CFP:
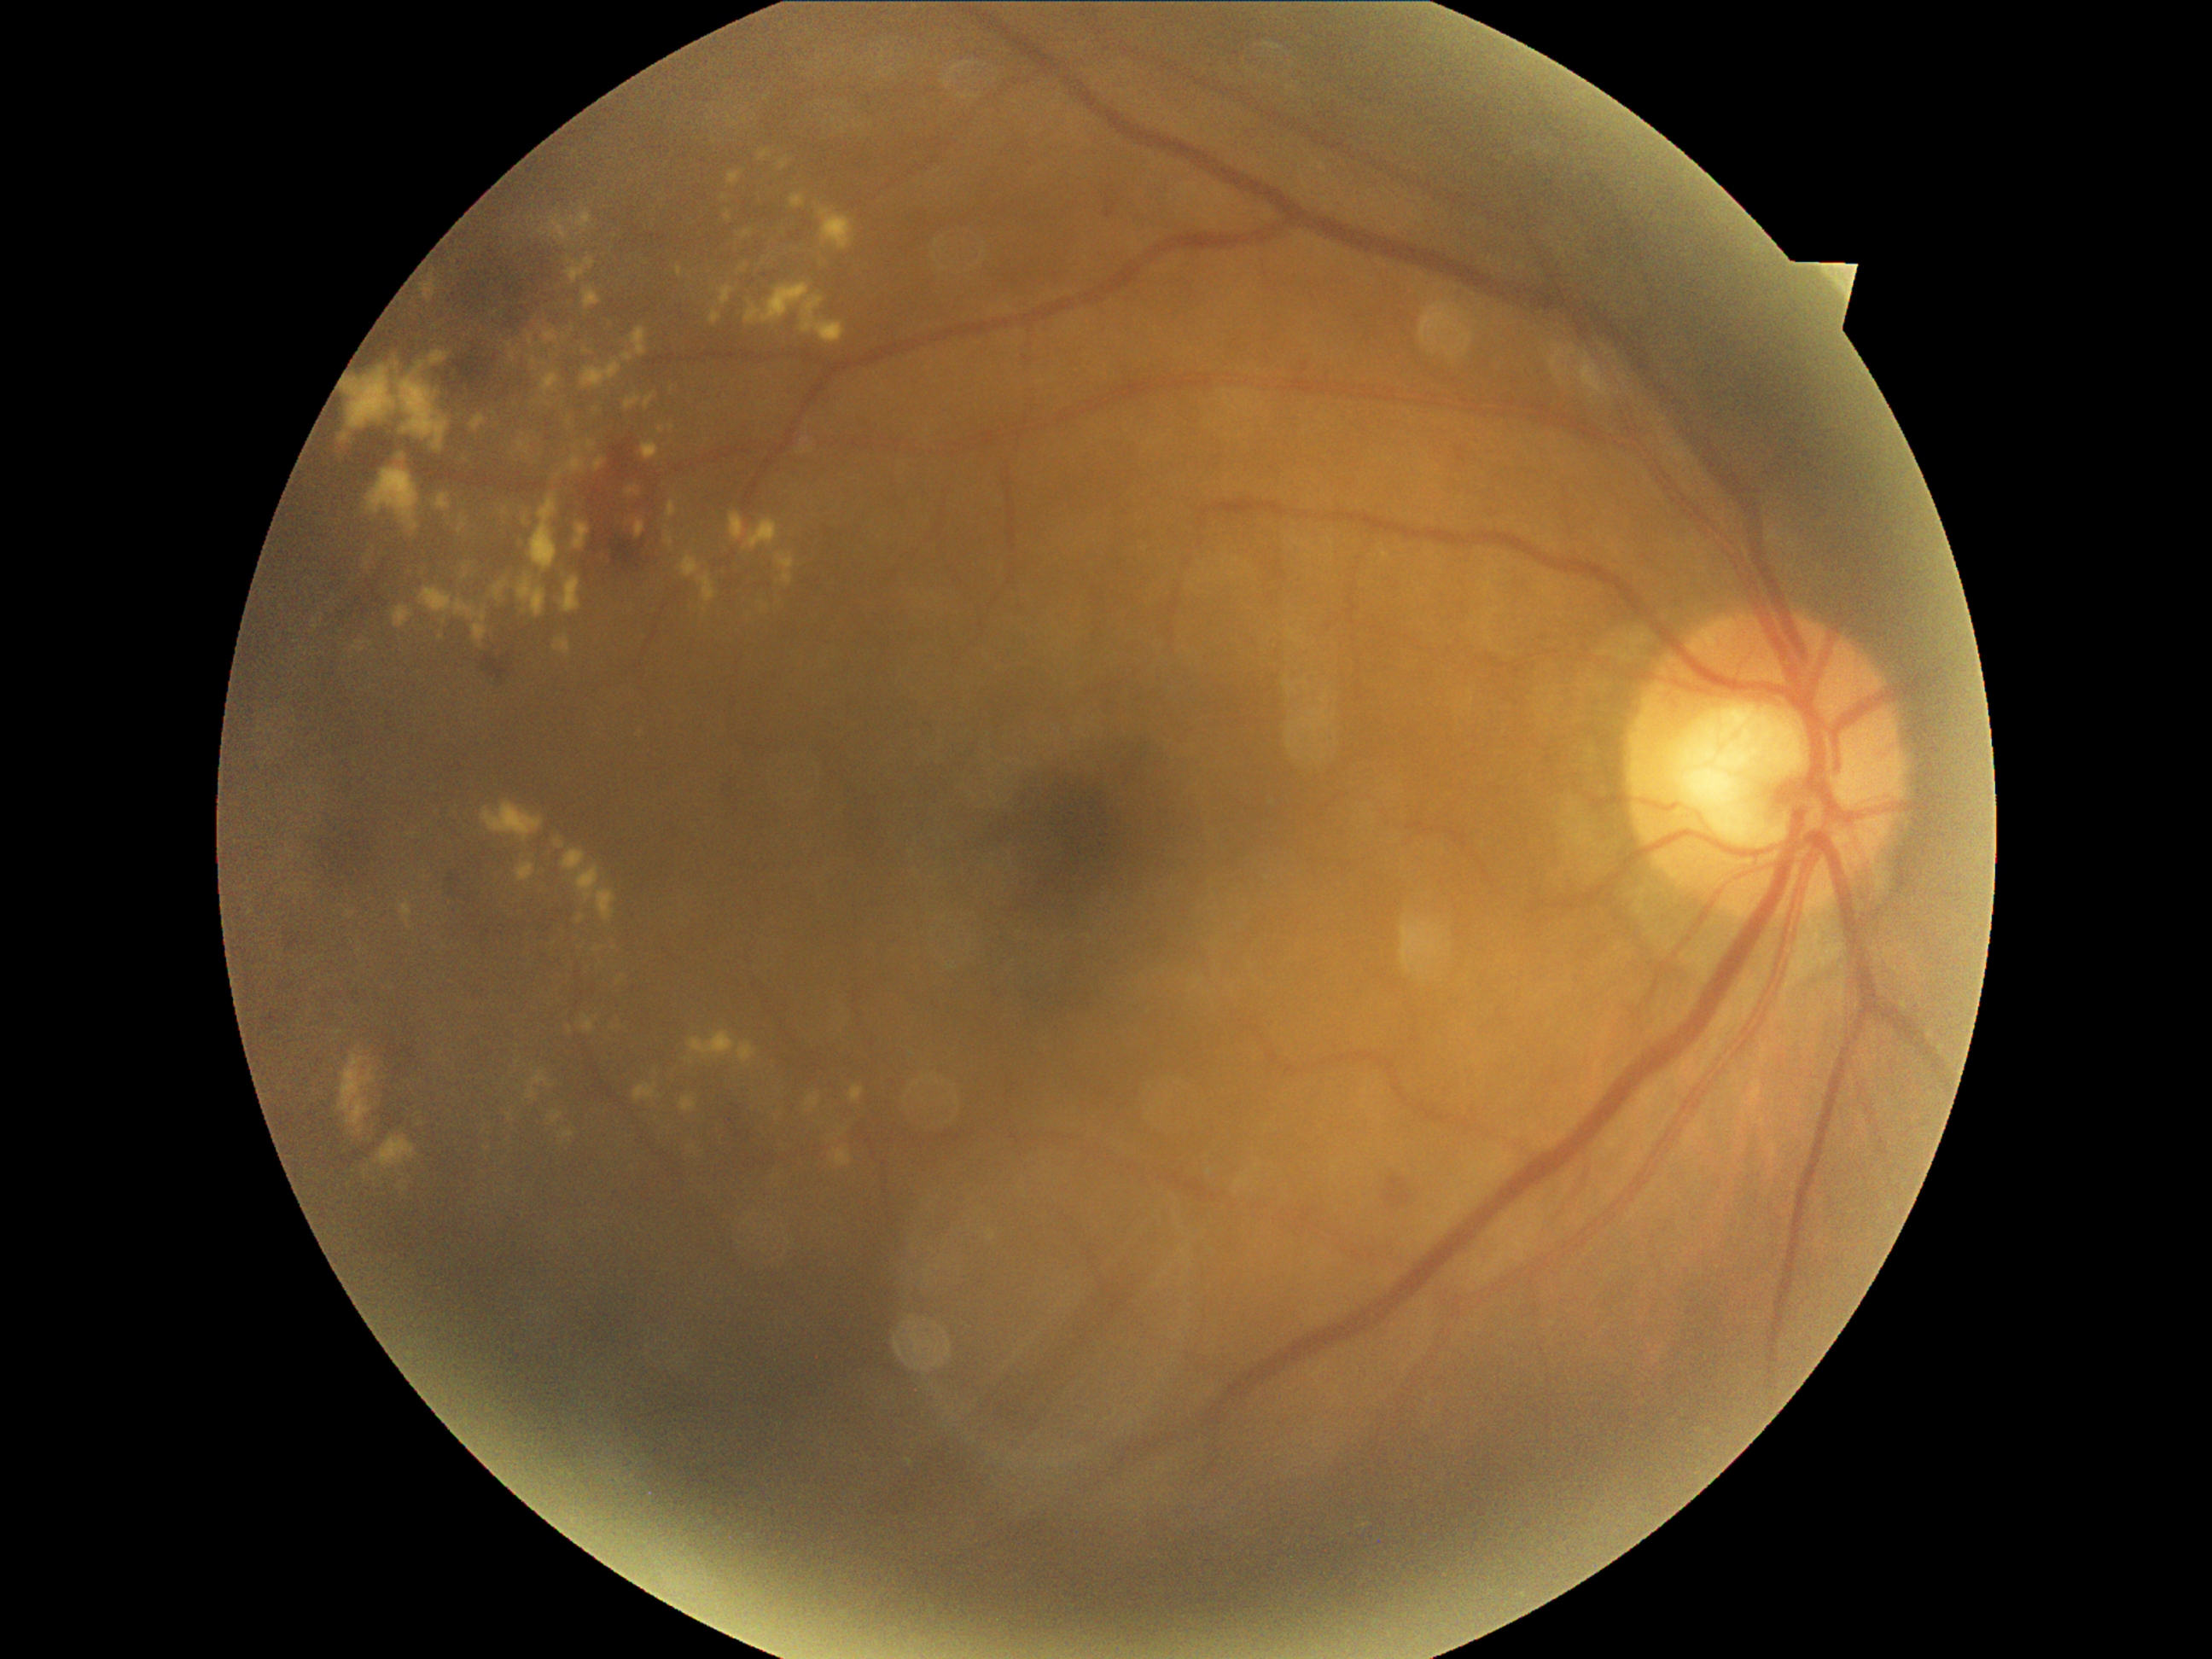

Diabetic retinopathy (DR) is 2/4.